Camera: Clarity RetCam 3 (130° FOV); RetCam wide-field infant fundus image:
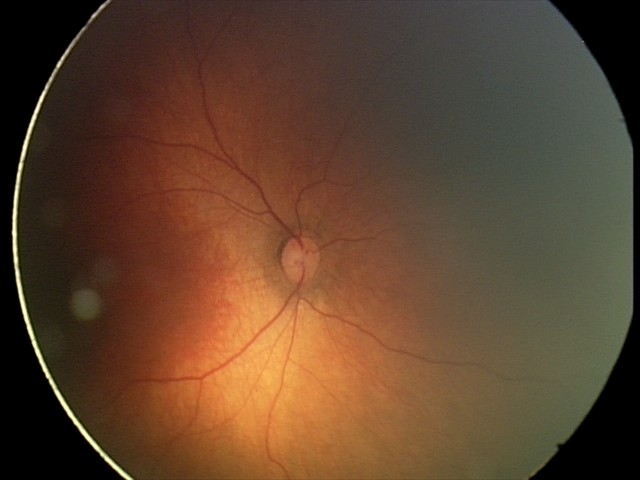

Q: What is the diagnosis from this examination?
A: physiological finding